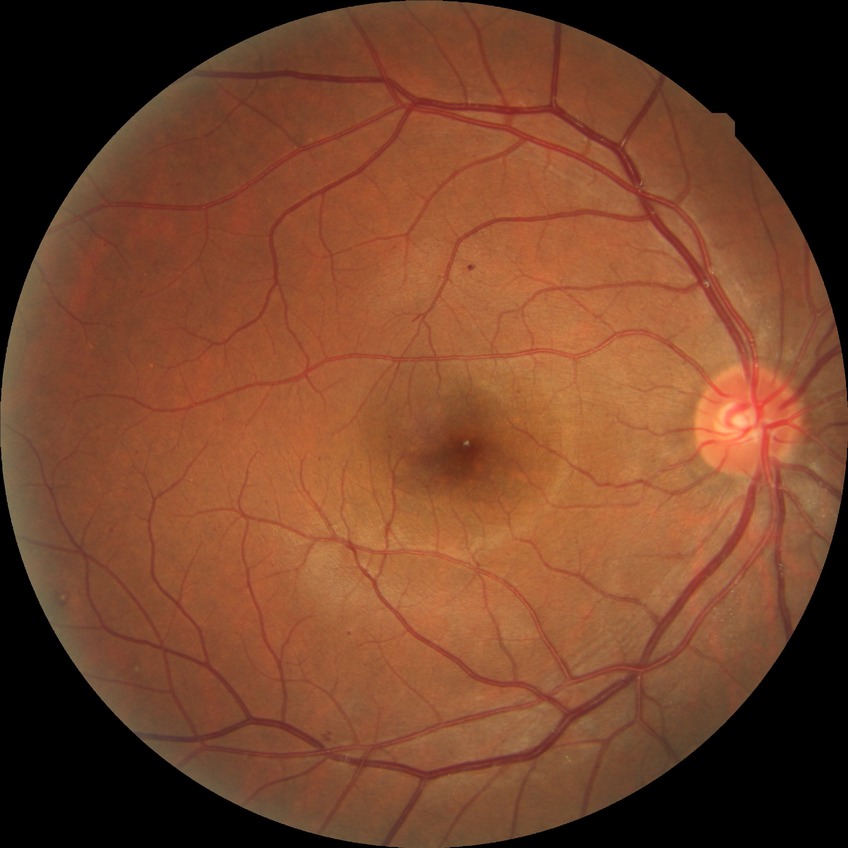
Assessment:
- Davis grading — simple diabetic retinopathy